Acquired with a NIDEK AFC-230
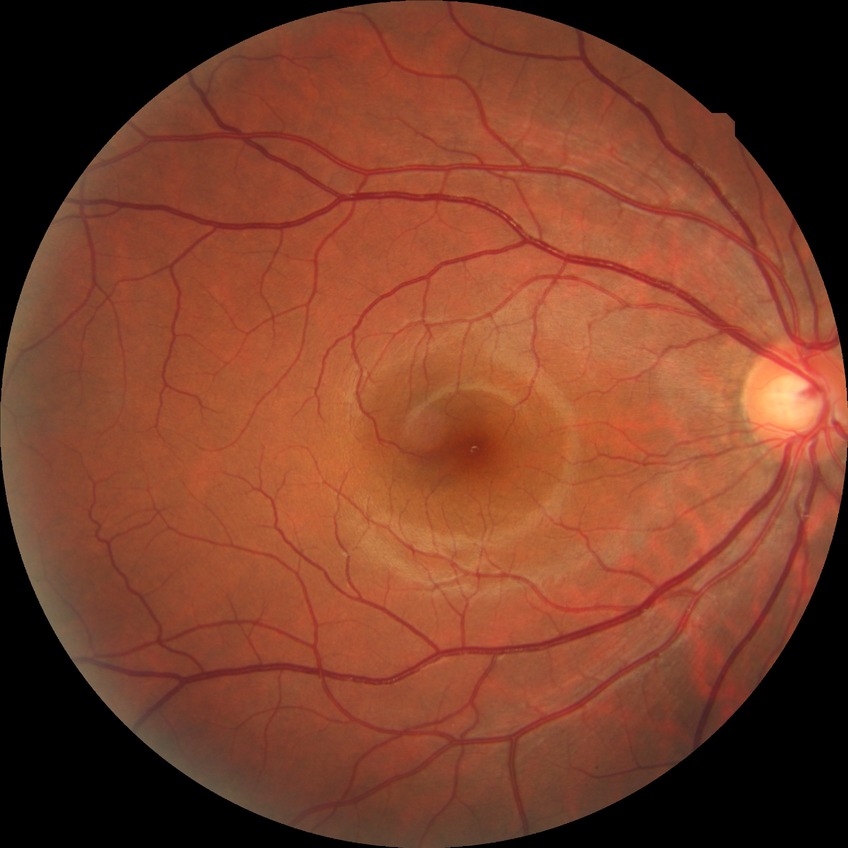

DR: NDR.